Image size 512x512: 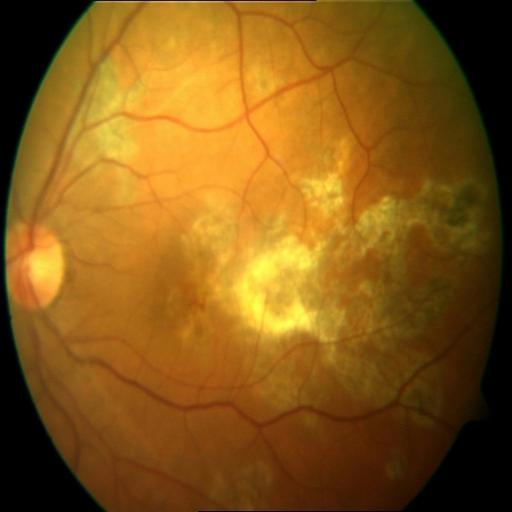 Fundus image with findings of macular scar (MS).